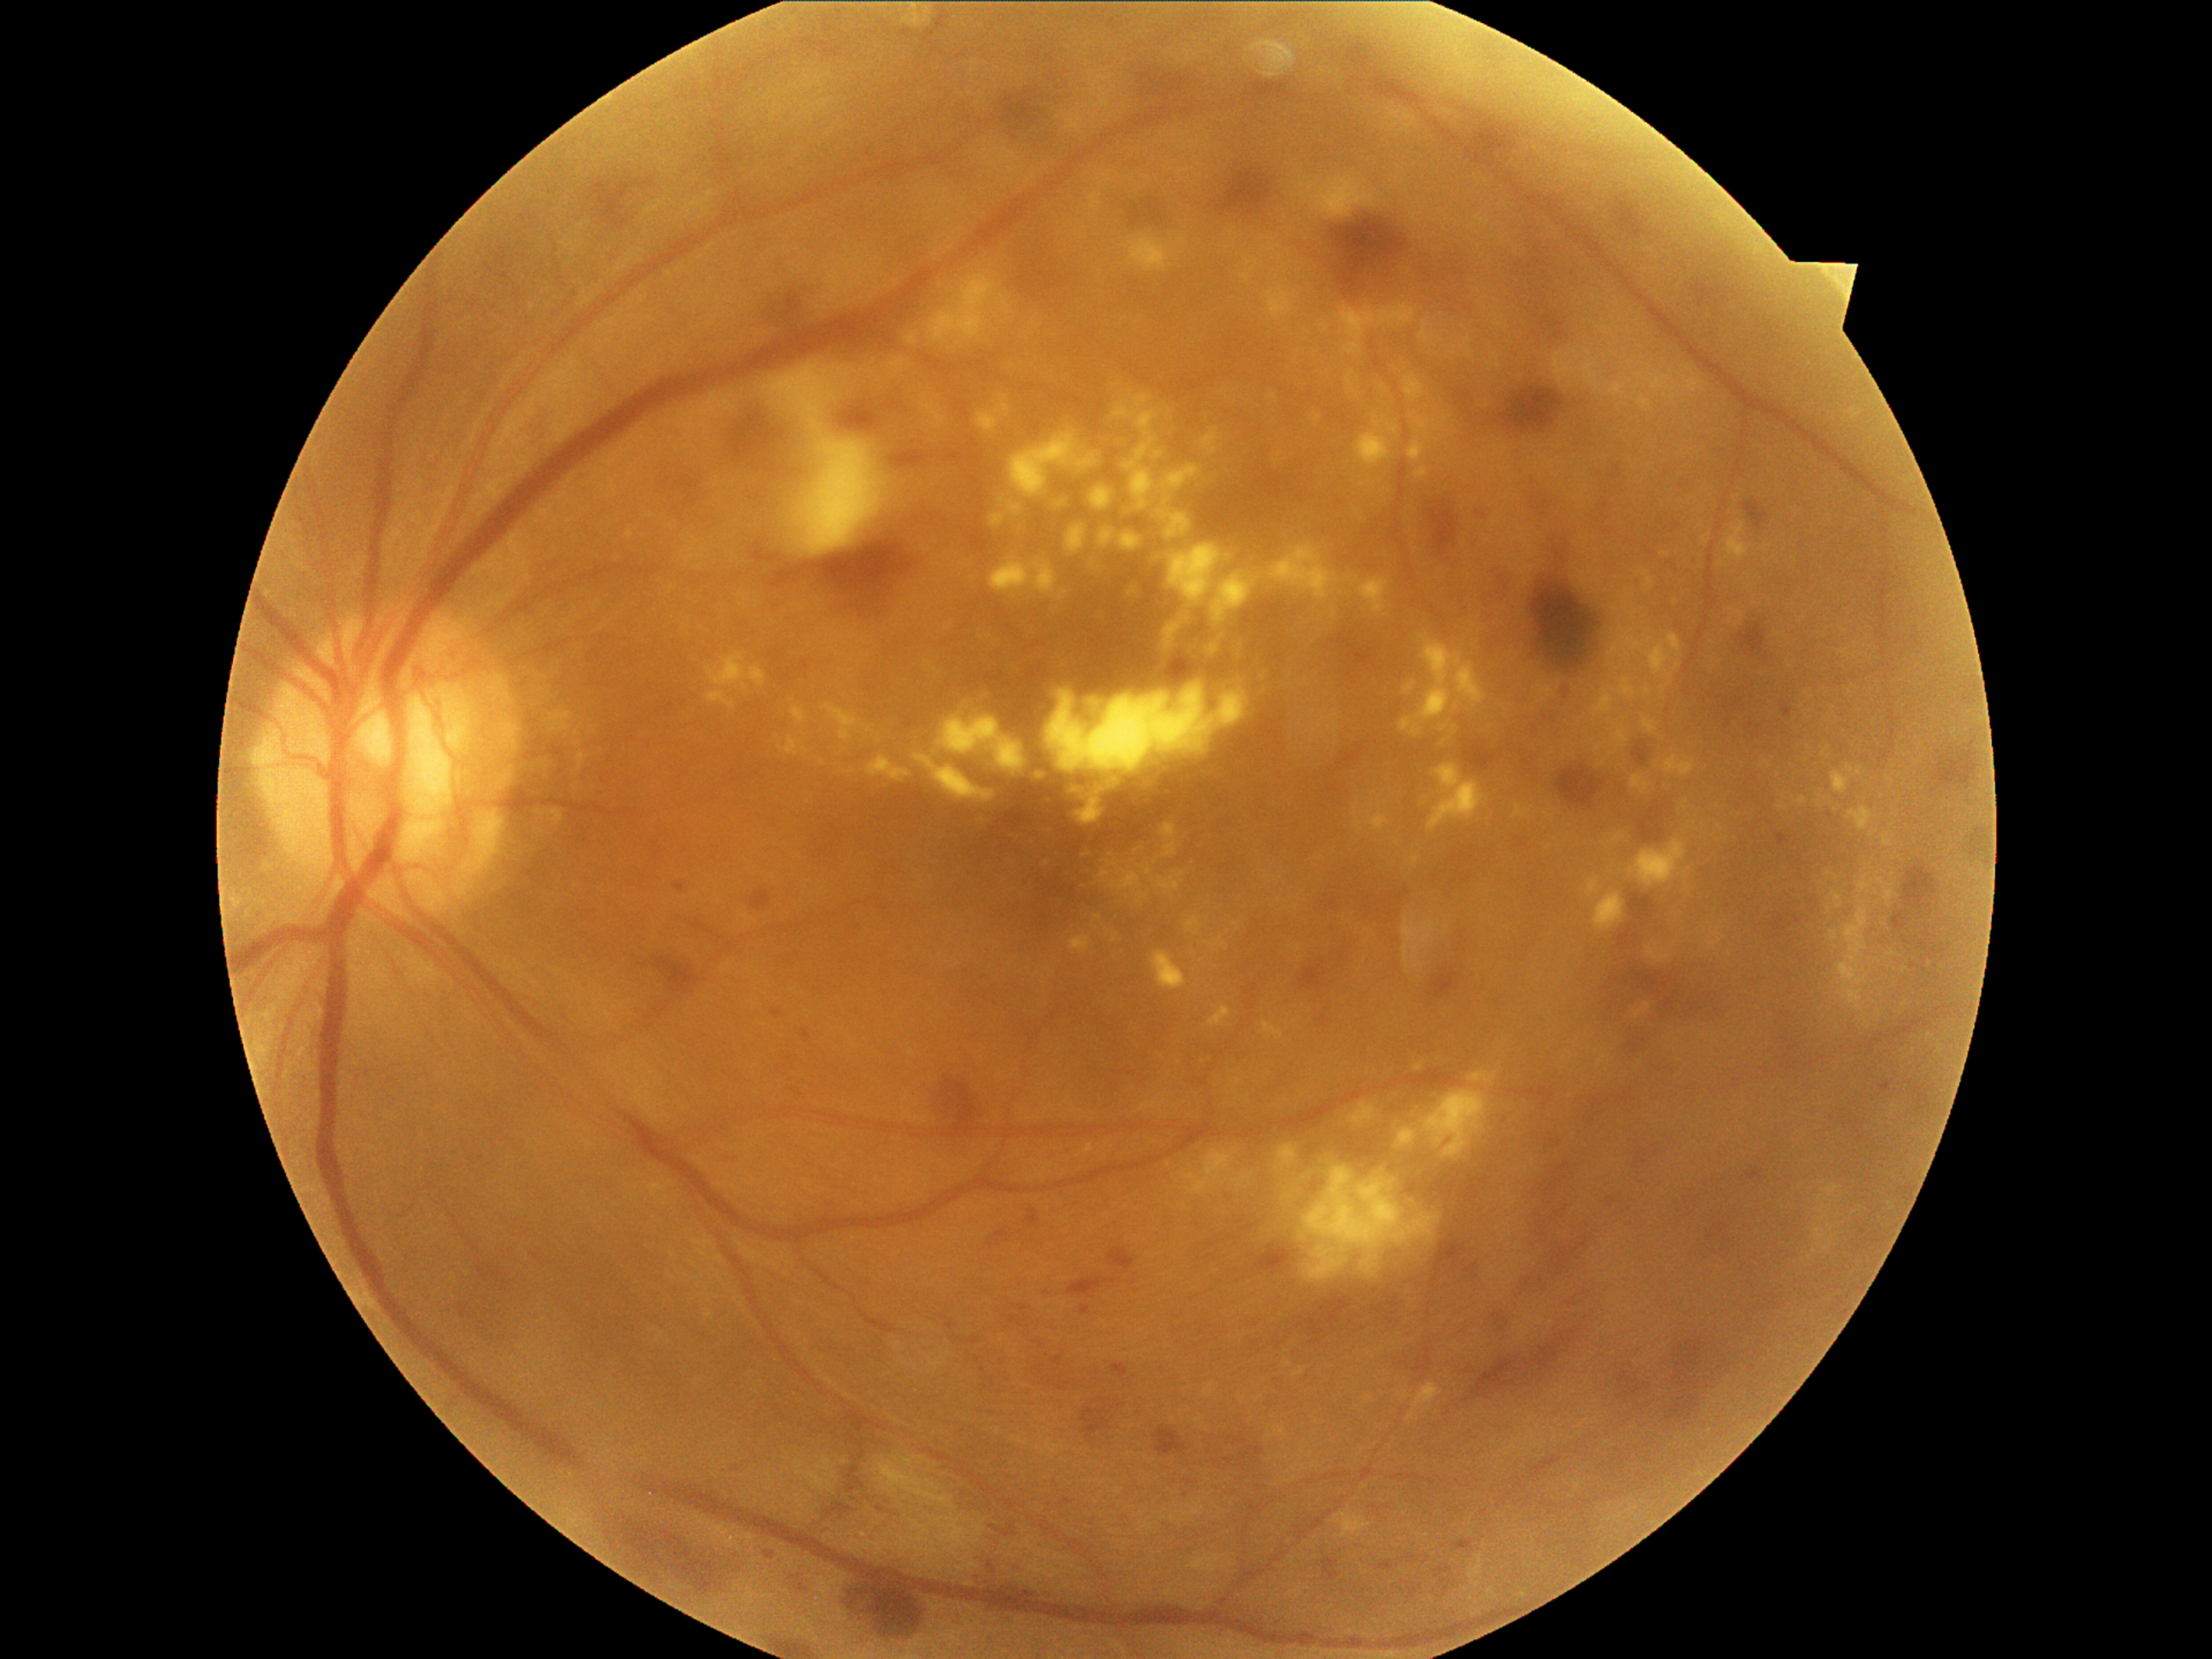

DR grade is severe NPDR (3).